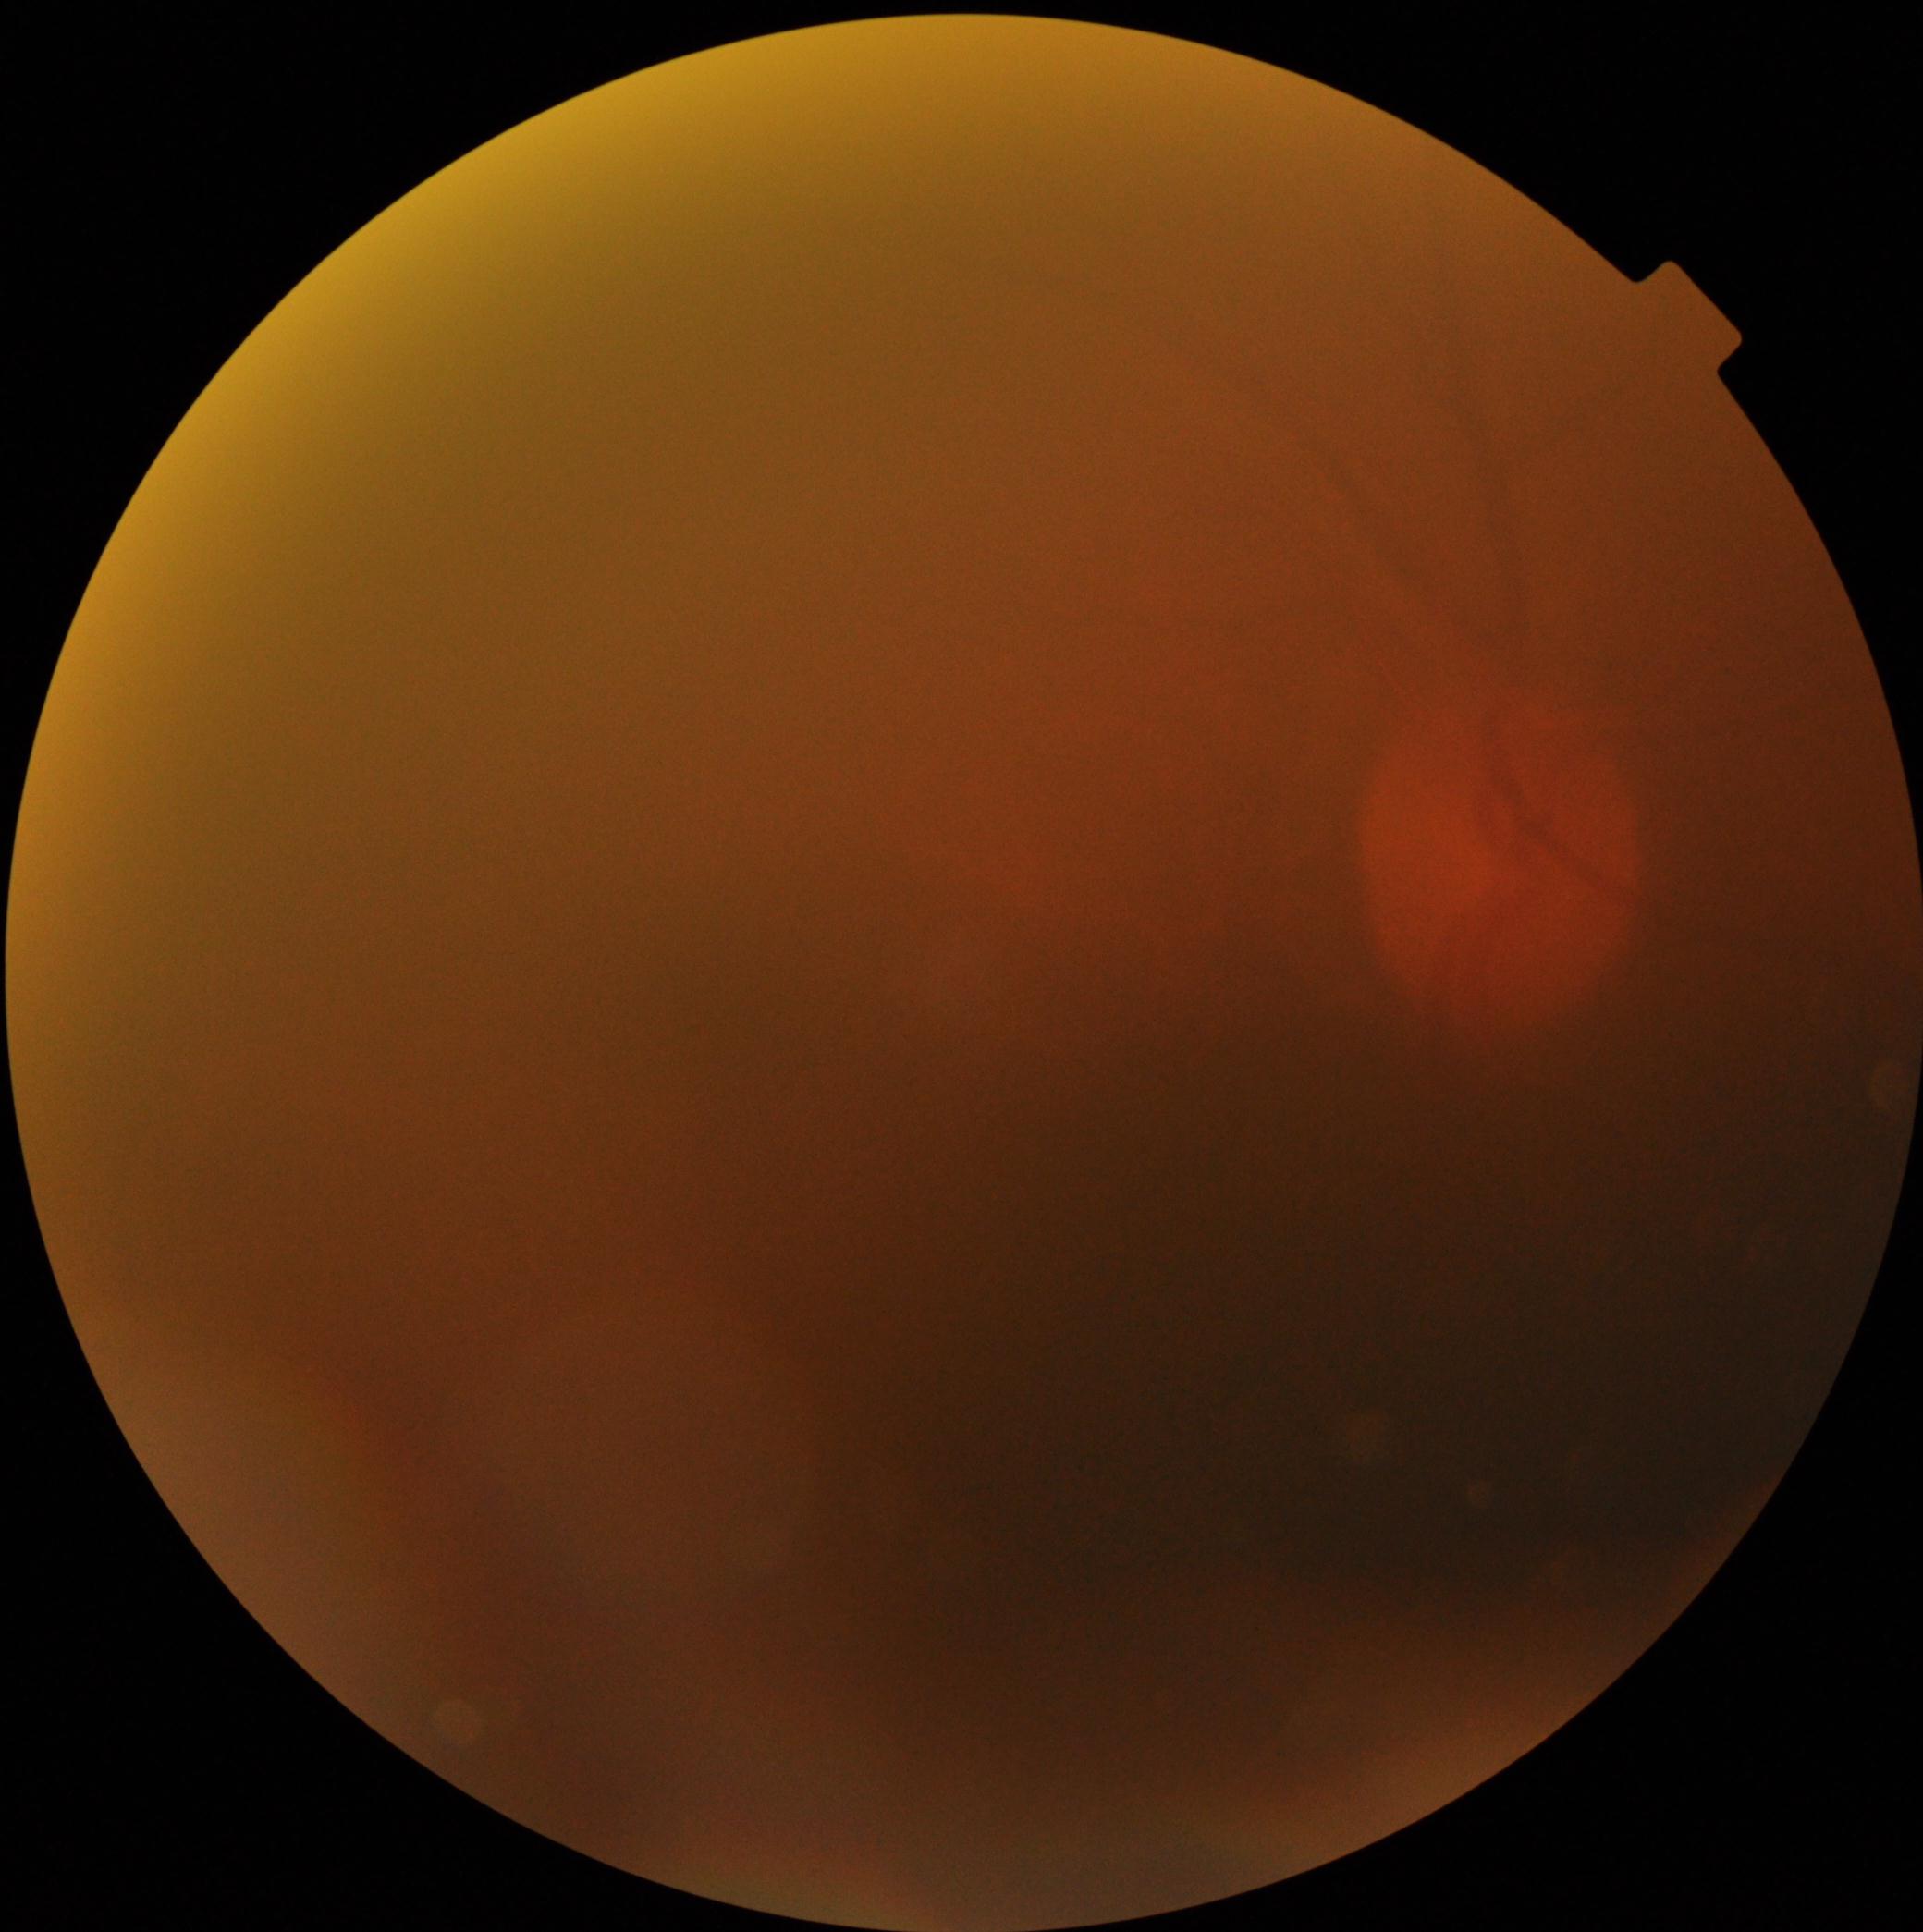

DR stage = ungradable
image quality = too poor for DR grading